NIDEK AFC-230 fundus camera; 45° field of view; 848x848; Davis DR grading.
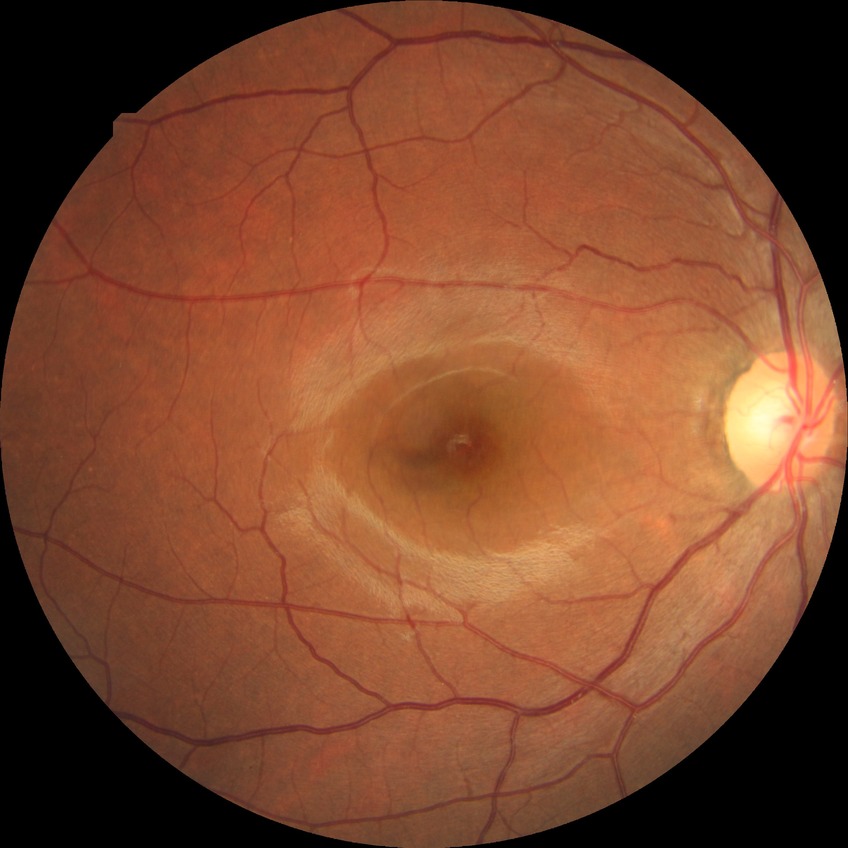

{
  "davis_grade": "NDR"
}